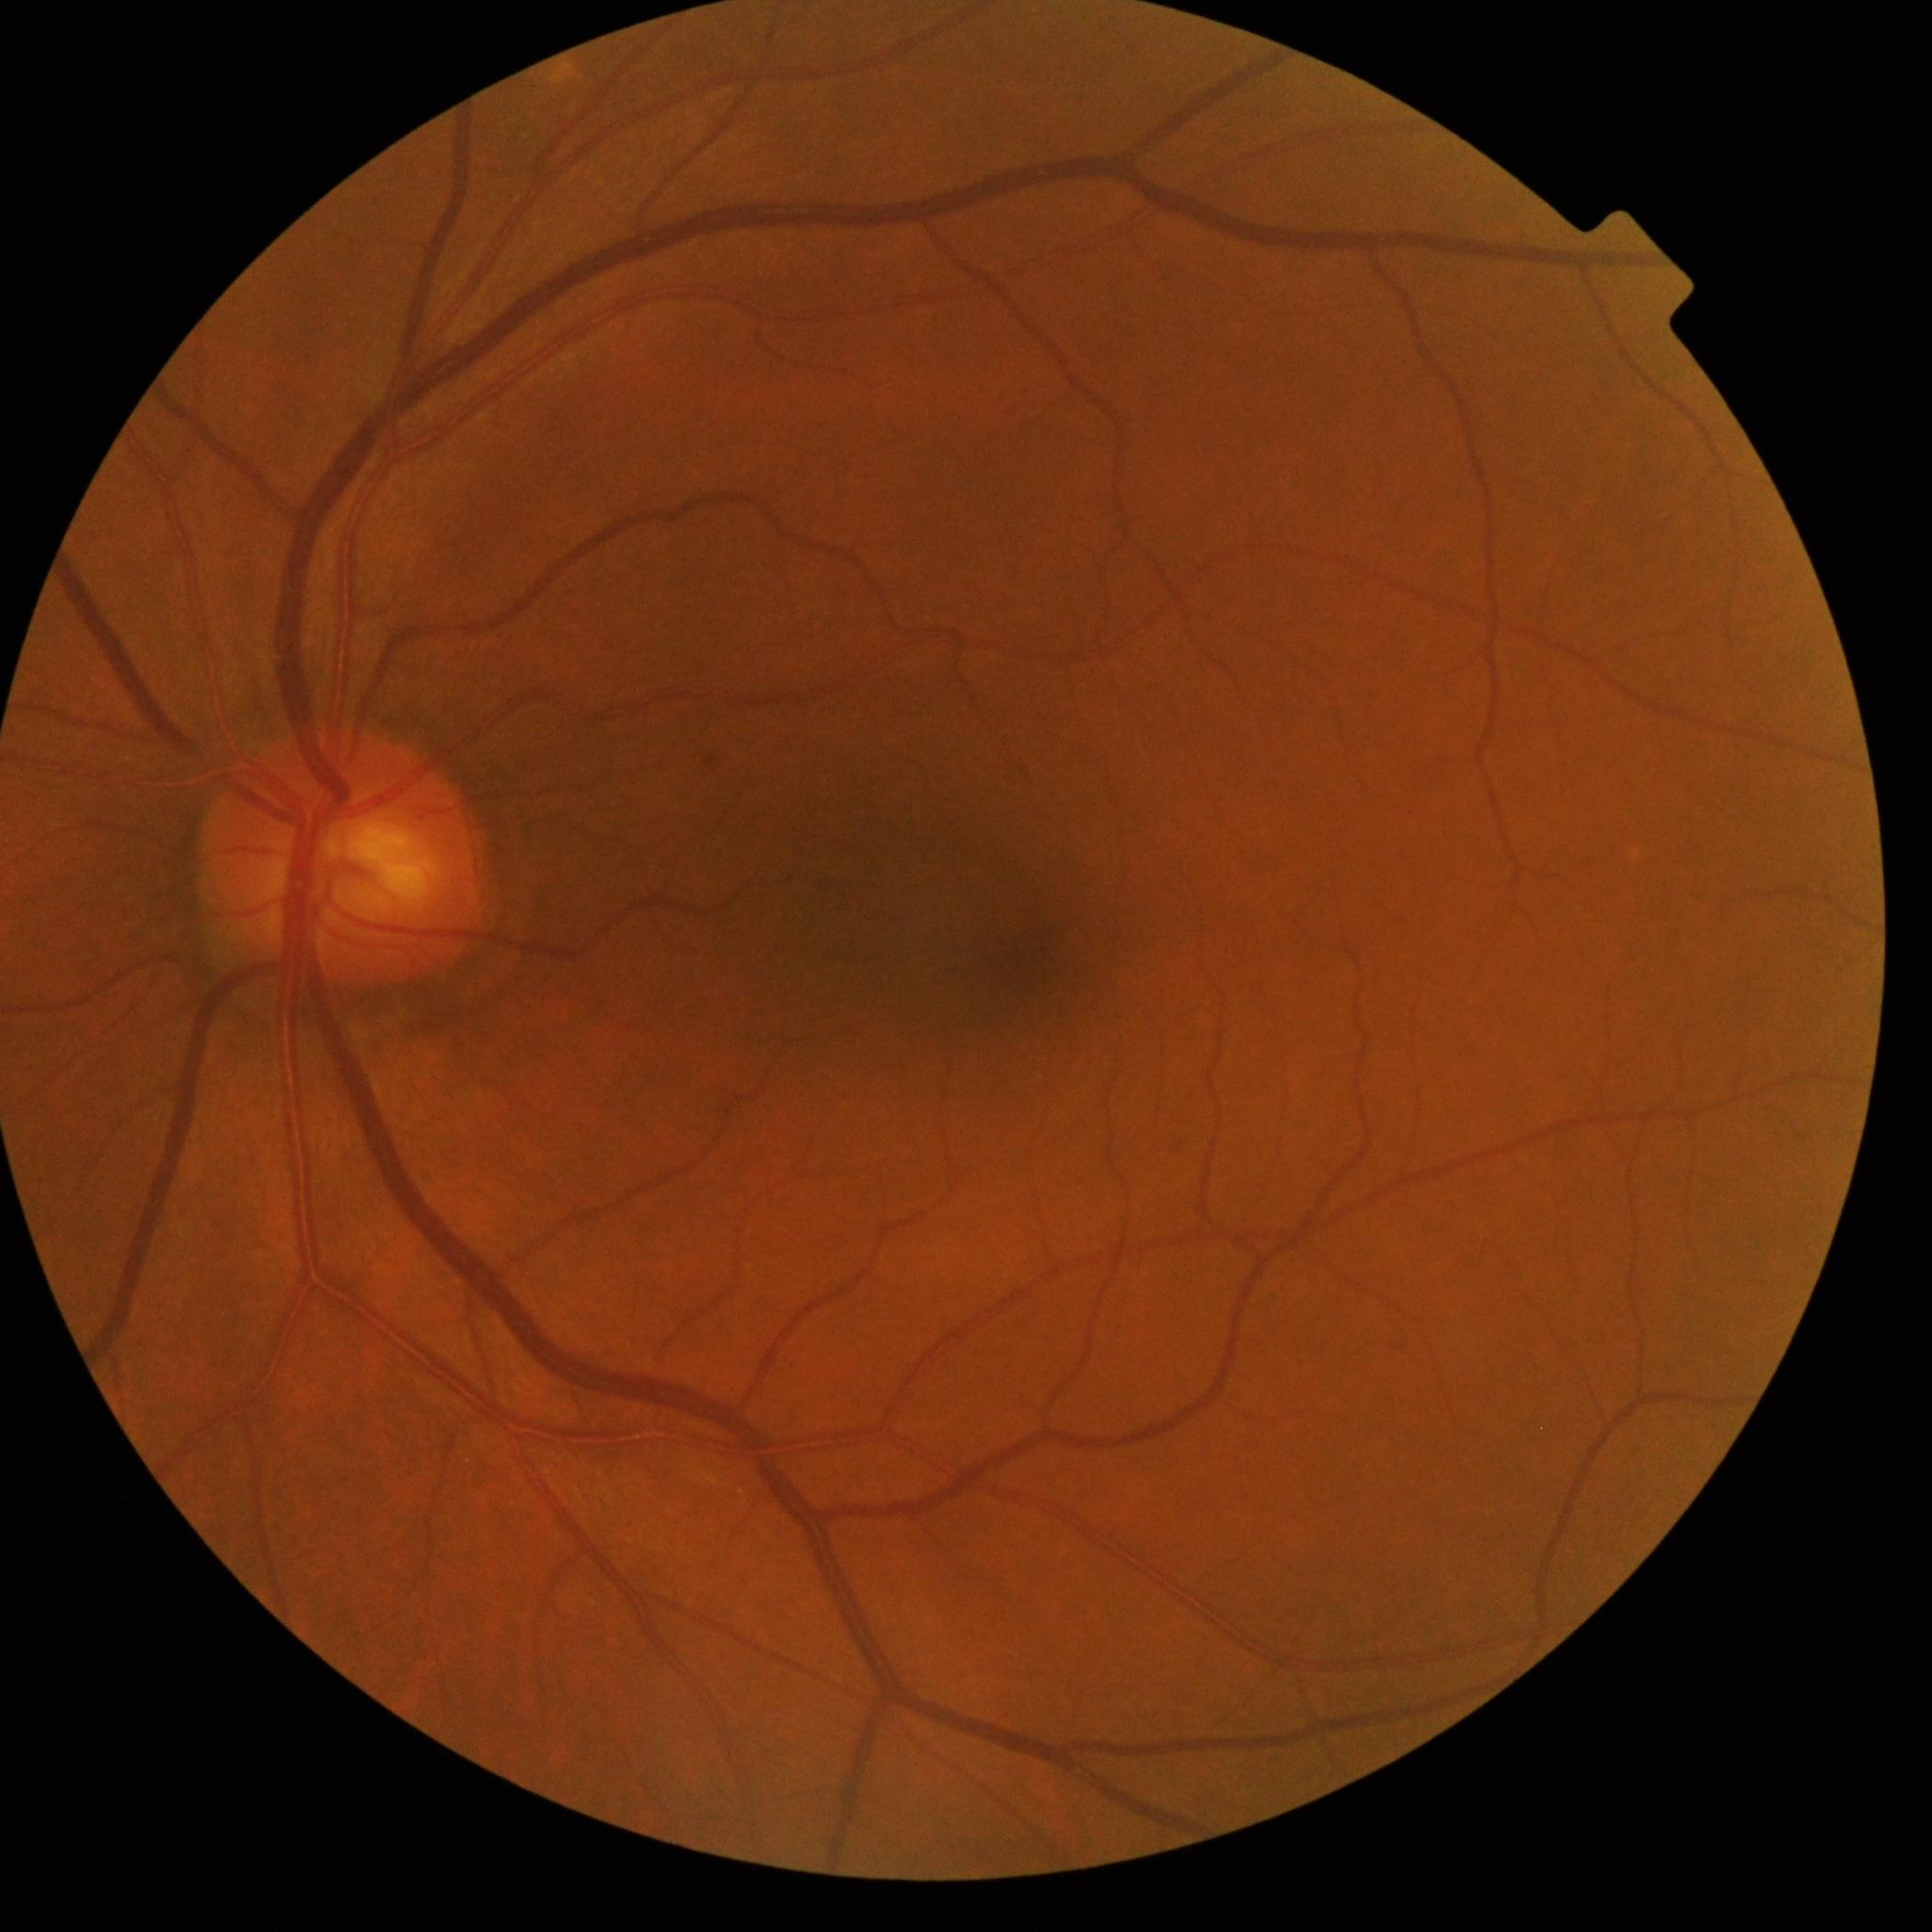

  dr_impression: no apparent DR
  dr_grade: 0 — no visible signs of diabetic retinopathy